Infant wide-field retinal image. 1240 by 1240 pixels: 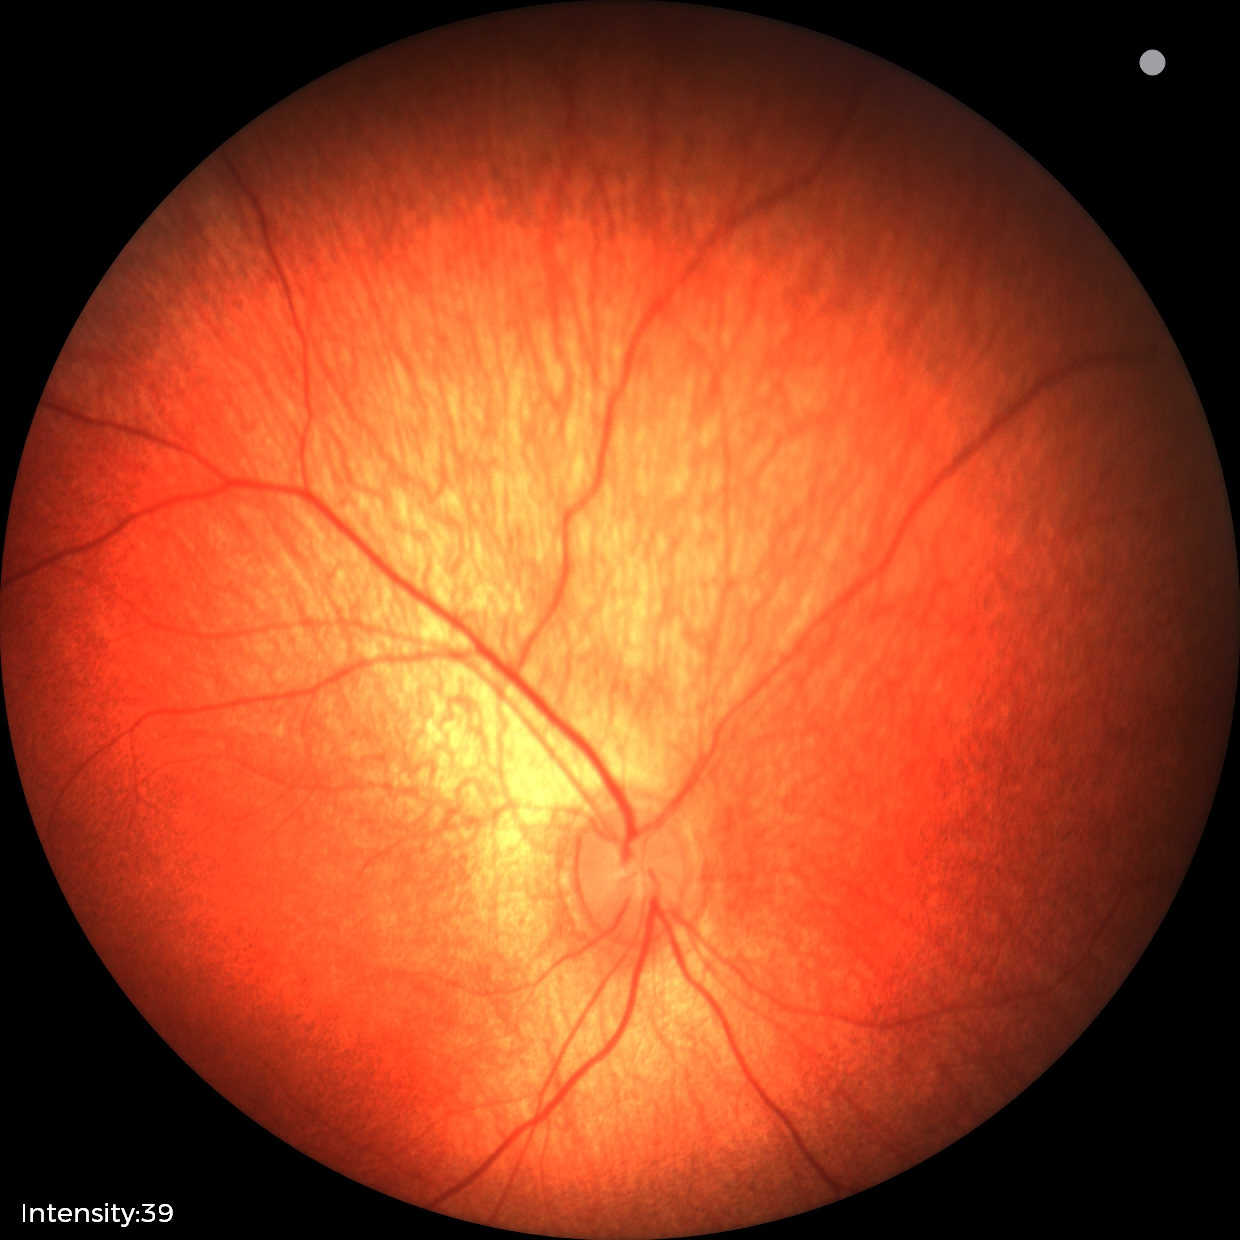

Impression: normal retinal appearance.